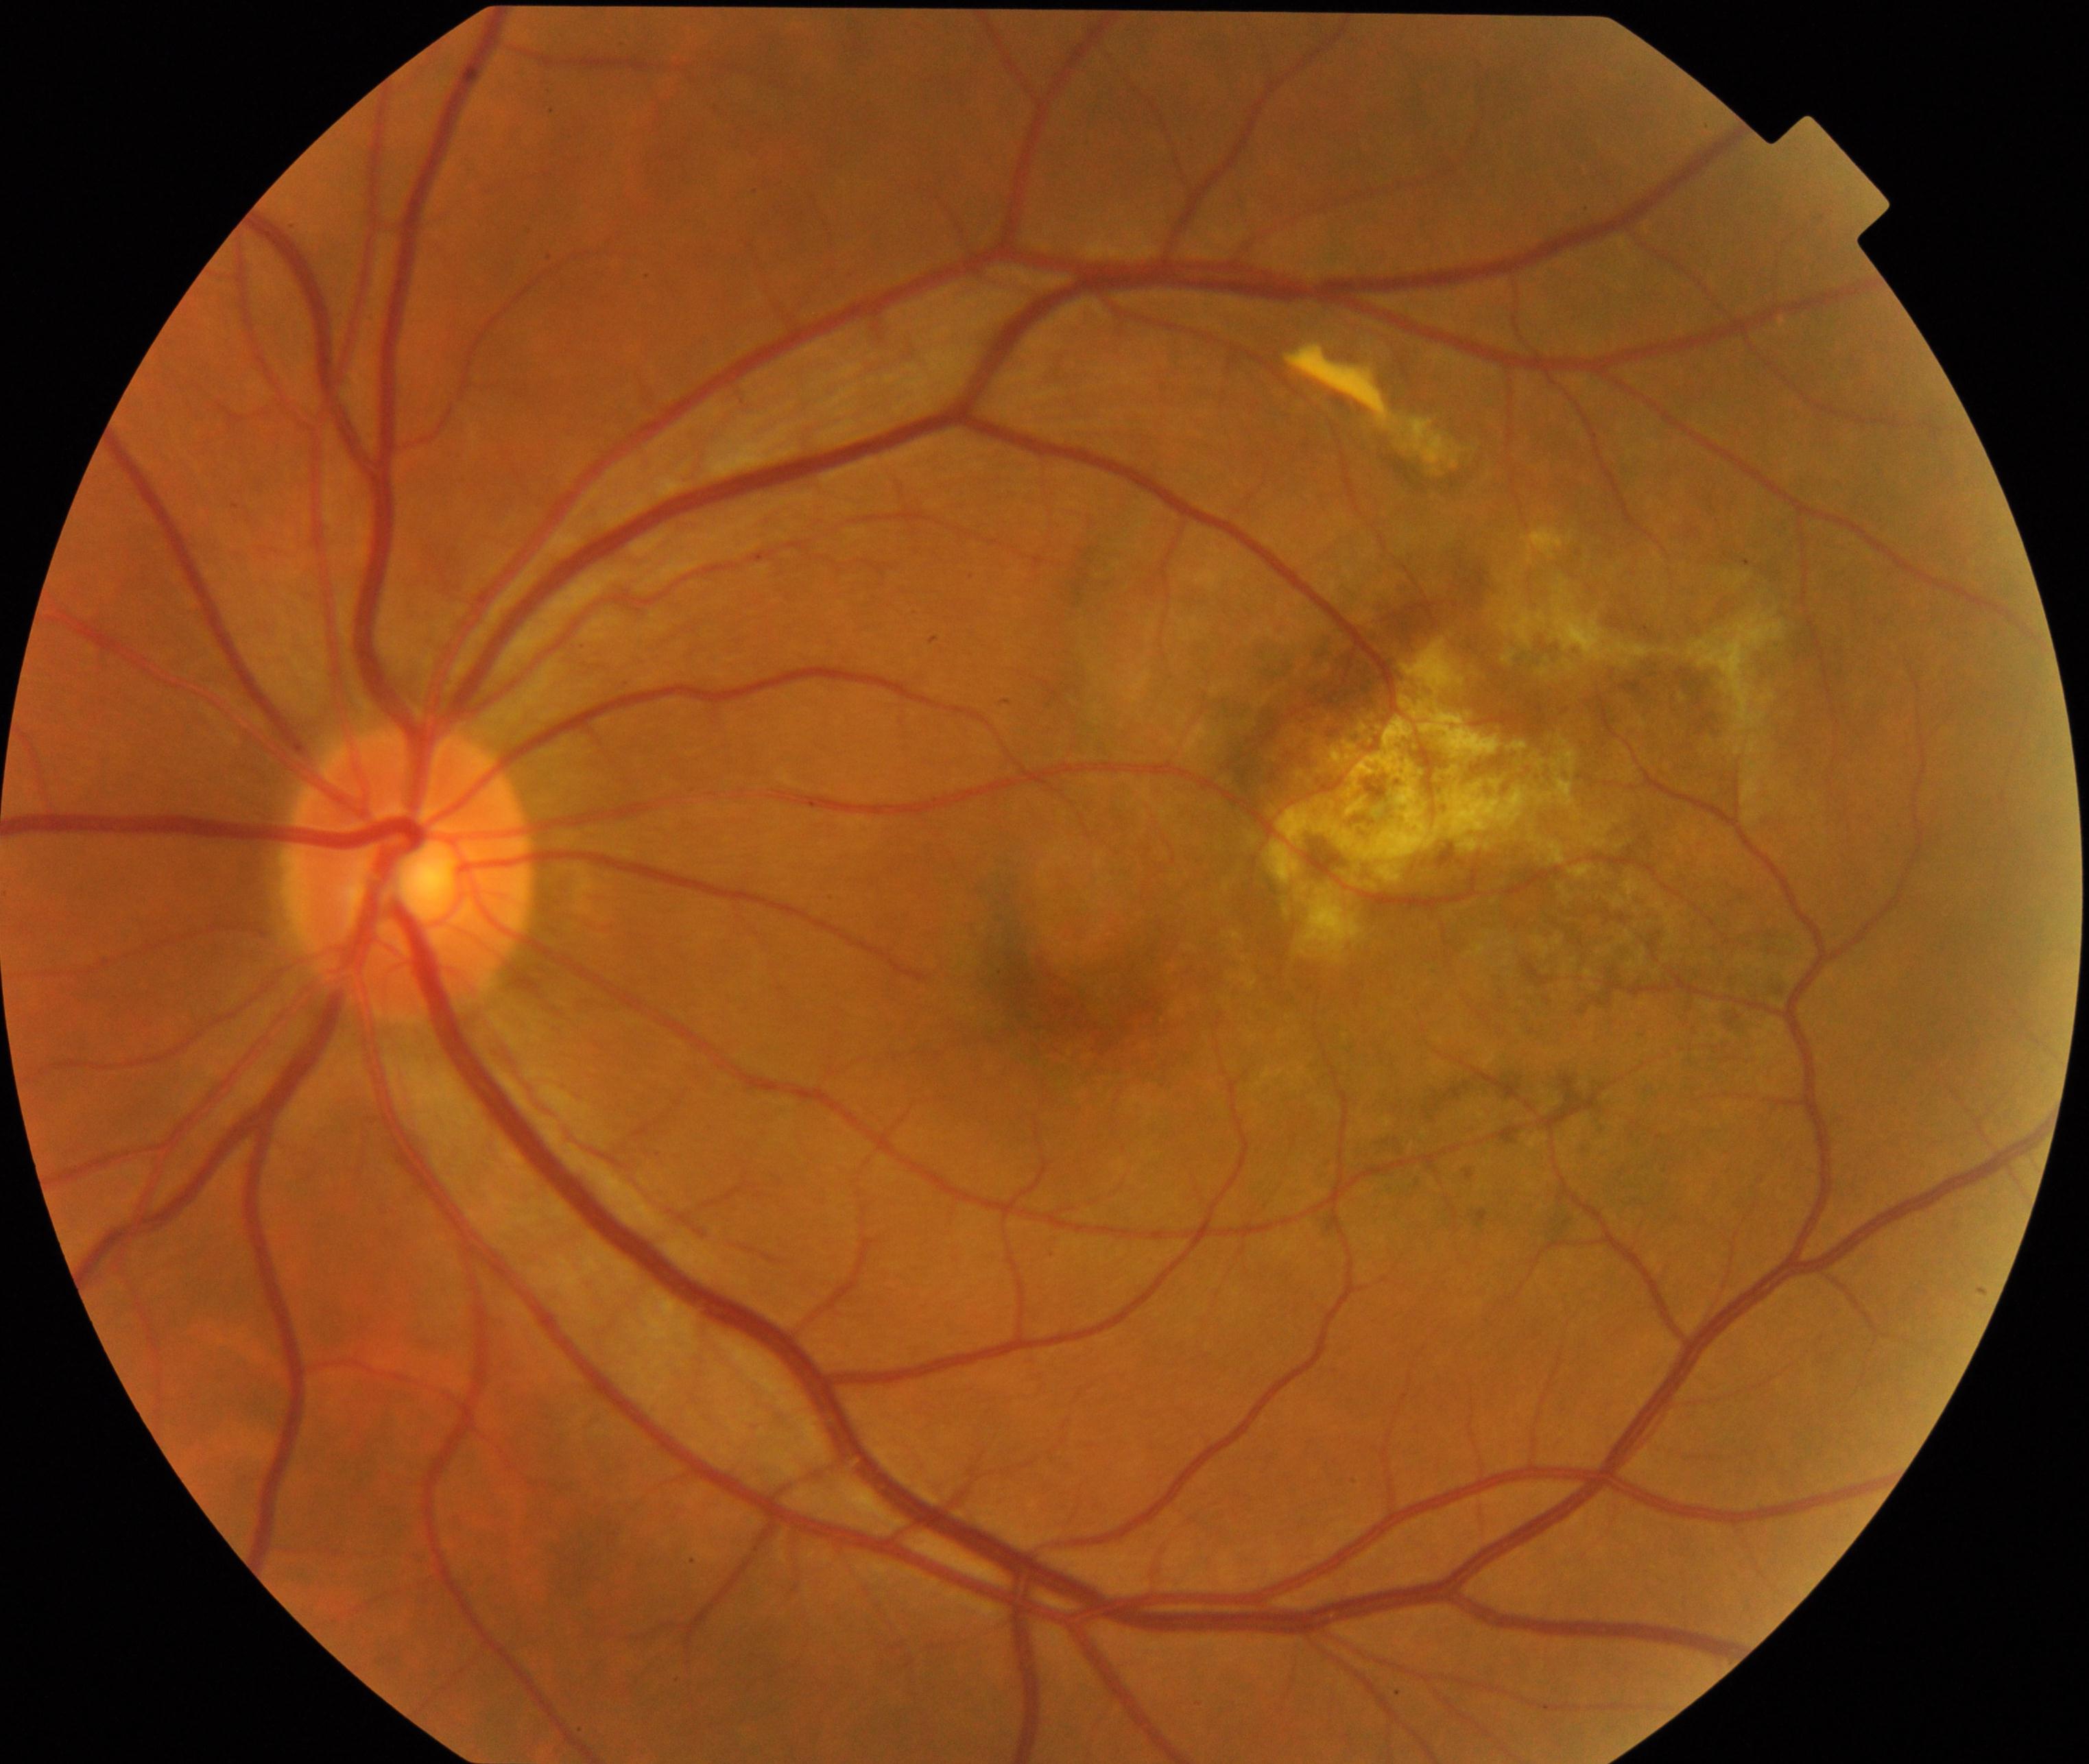 Impression: maculopathy.